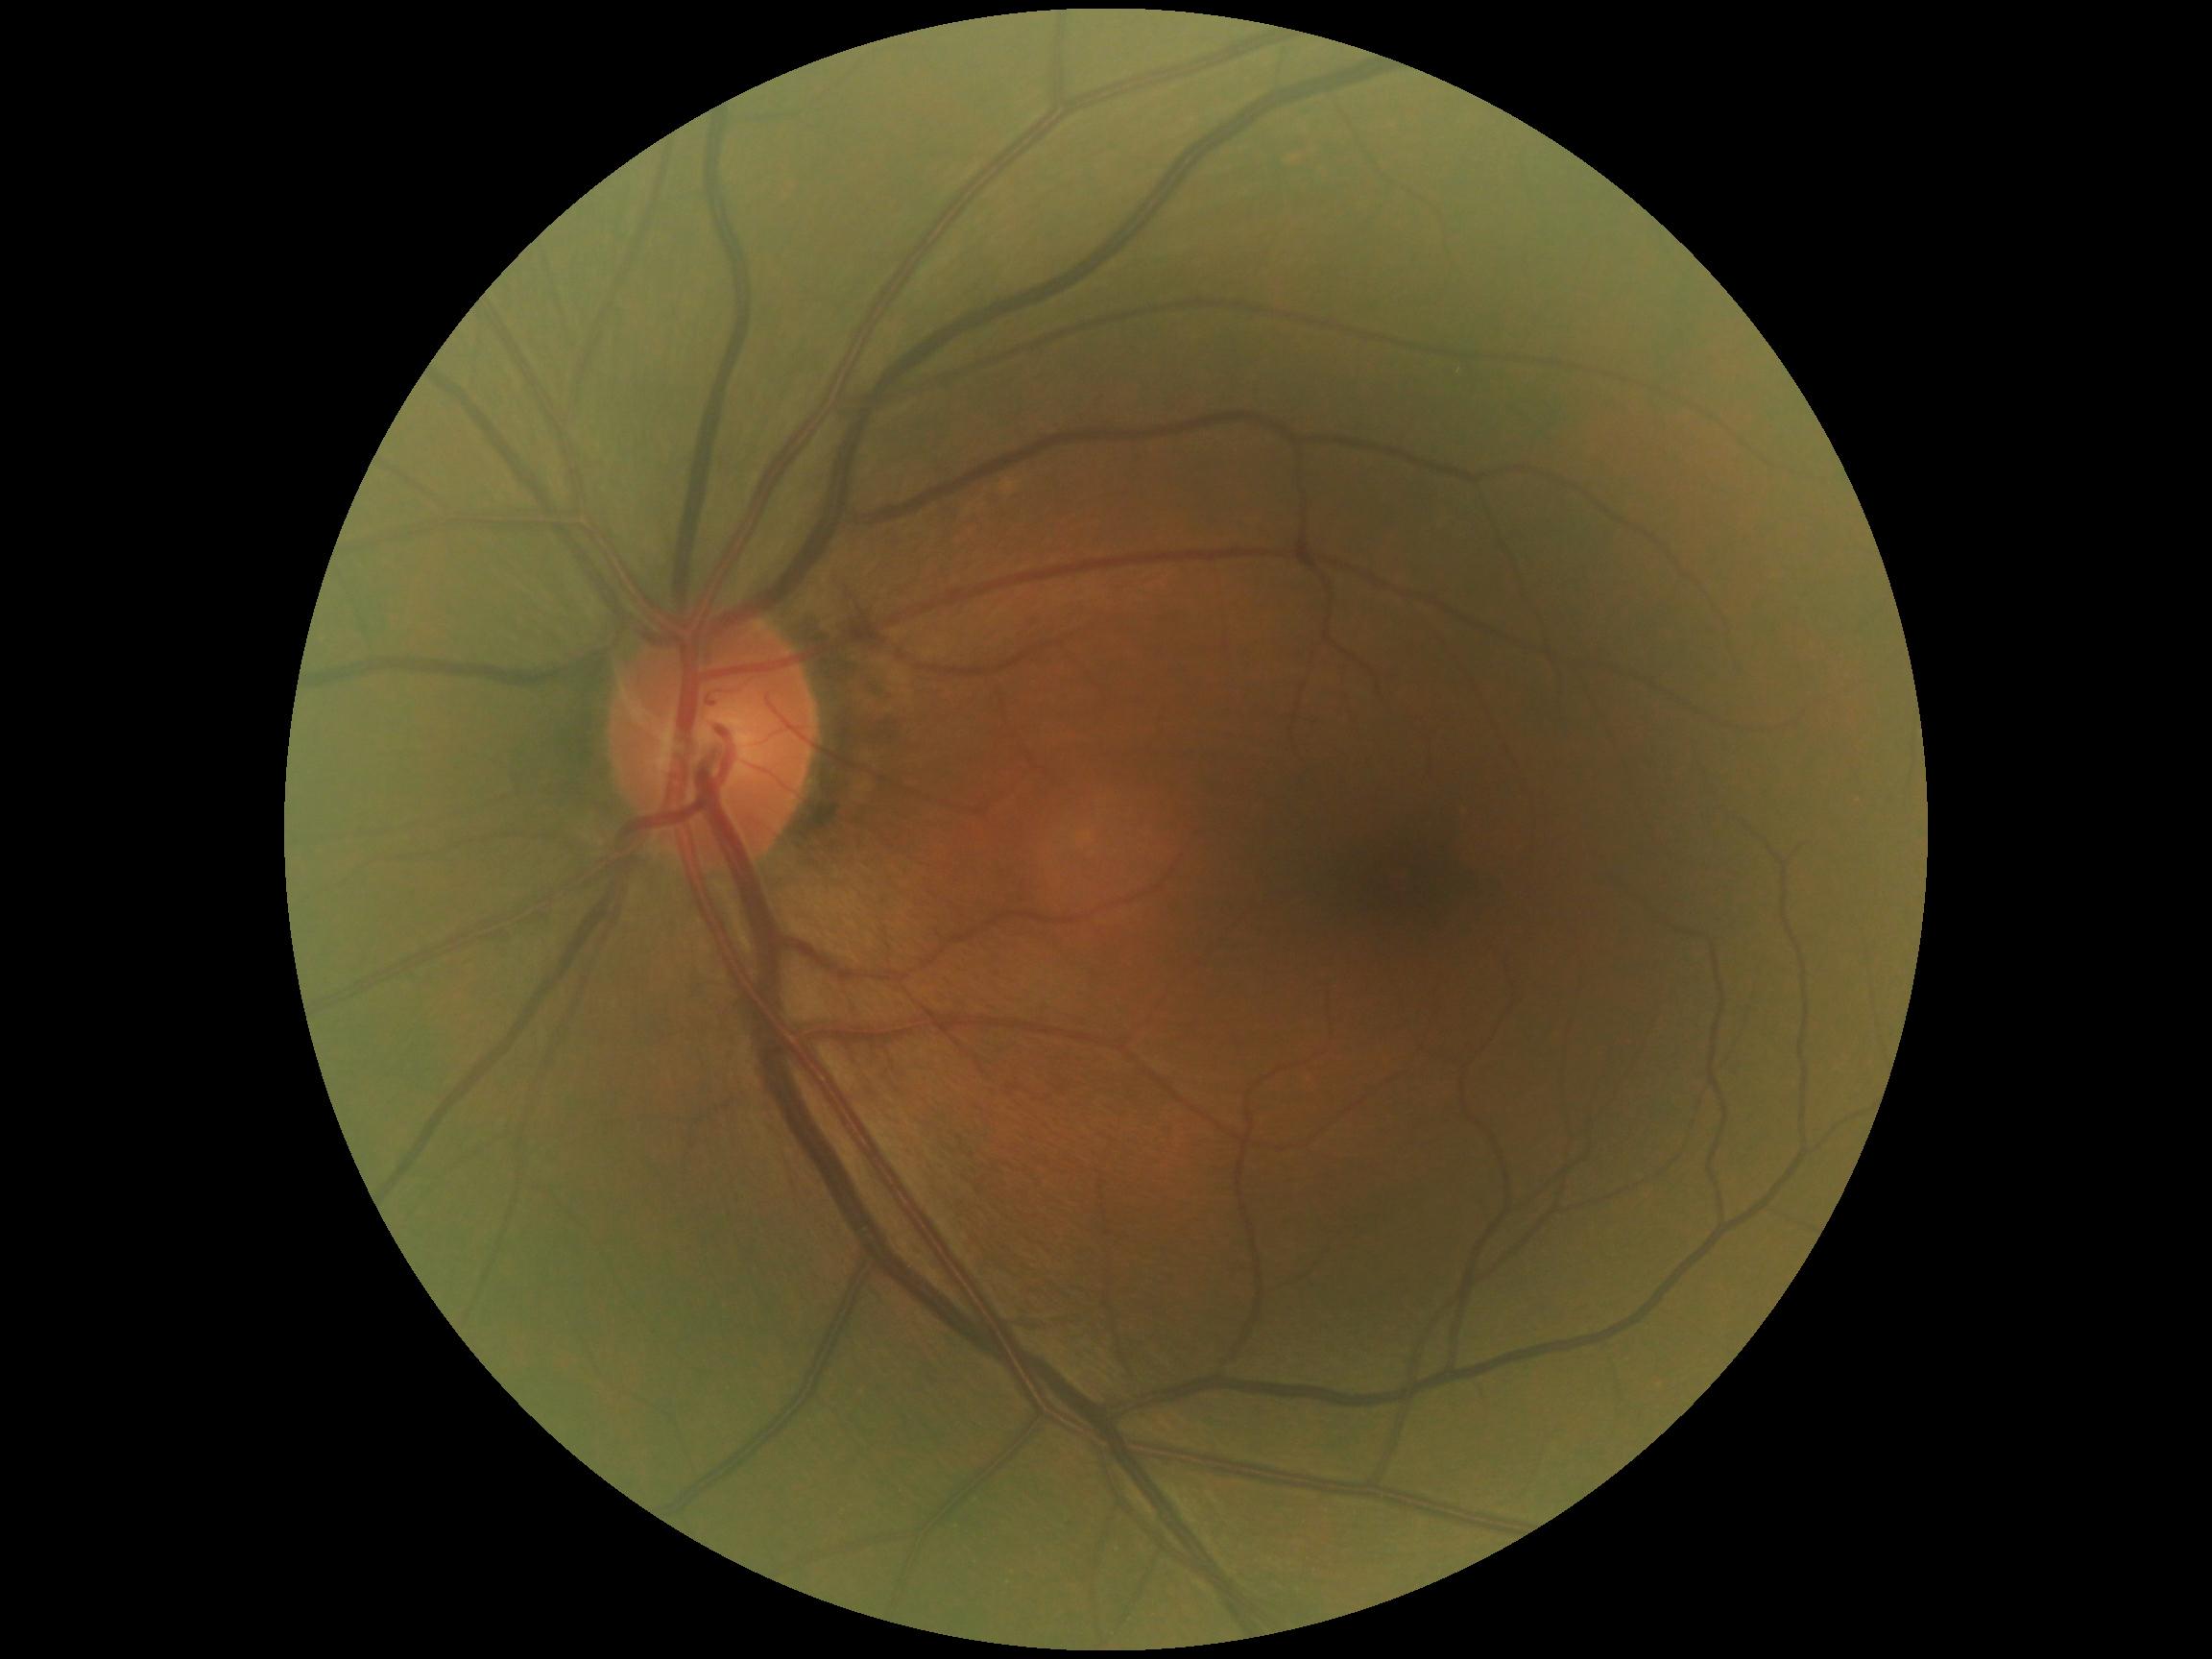

dr_grade: grade 0 (no apparent retinopathy)